Diabetic retinopathy graded by the modified Davis classification. Camera: NIDEK AFC-230. 848 x 848 pixels.
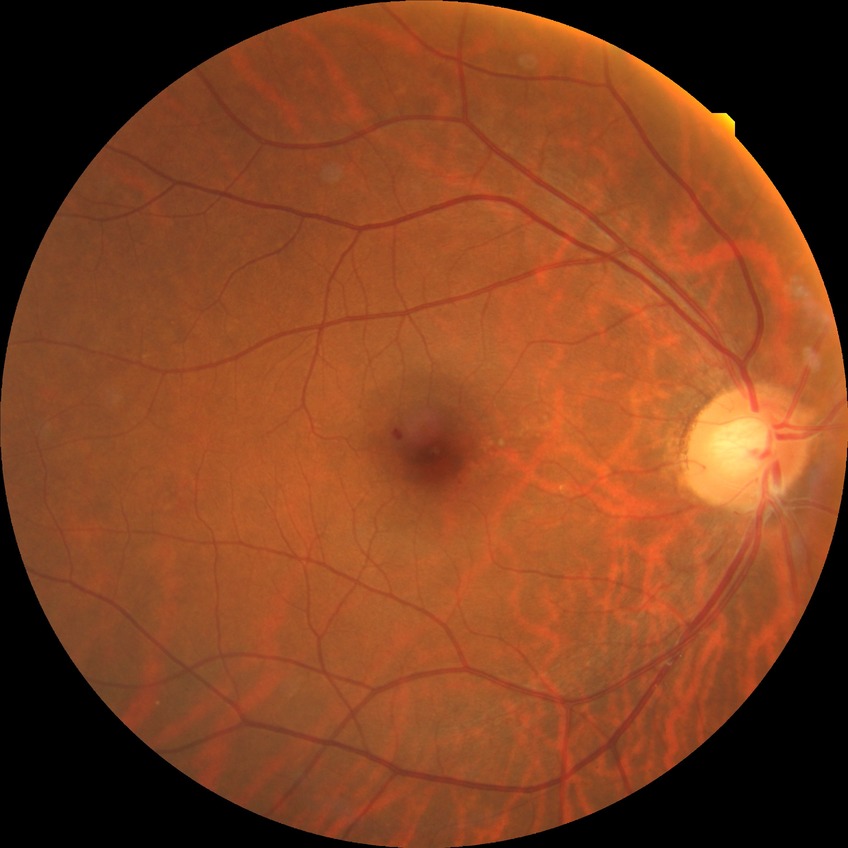
Diabetic retinopathy severity is simple diabetic retinopathy.